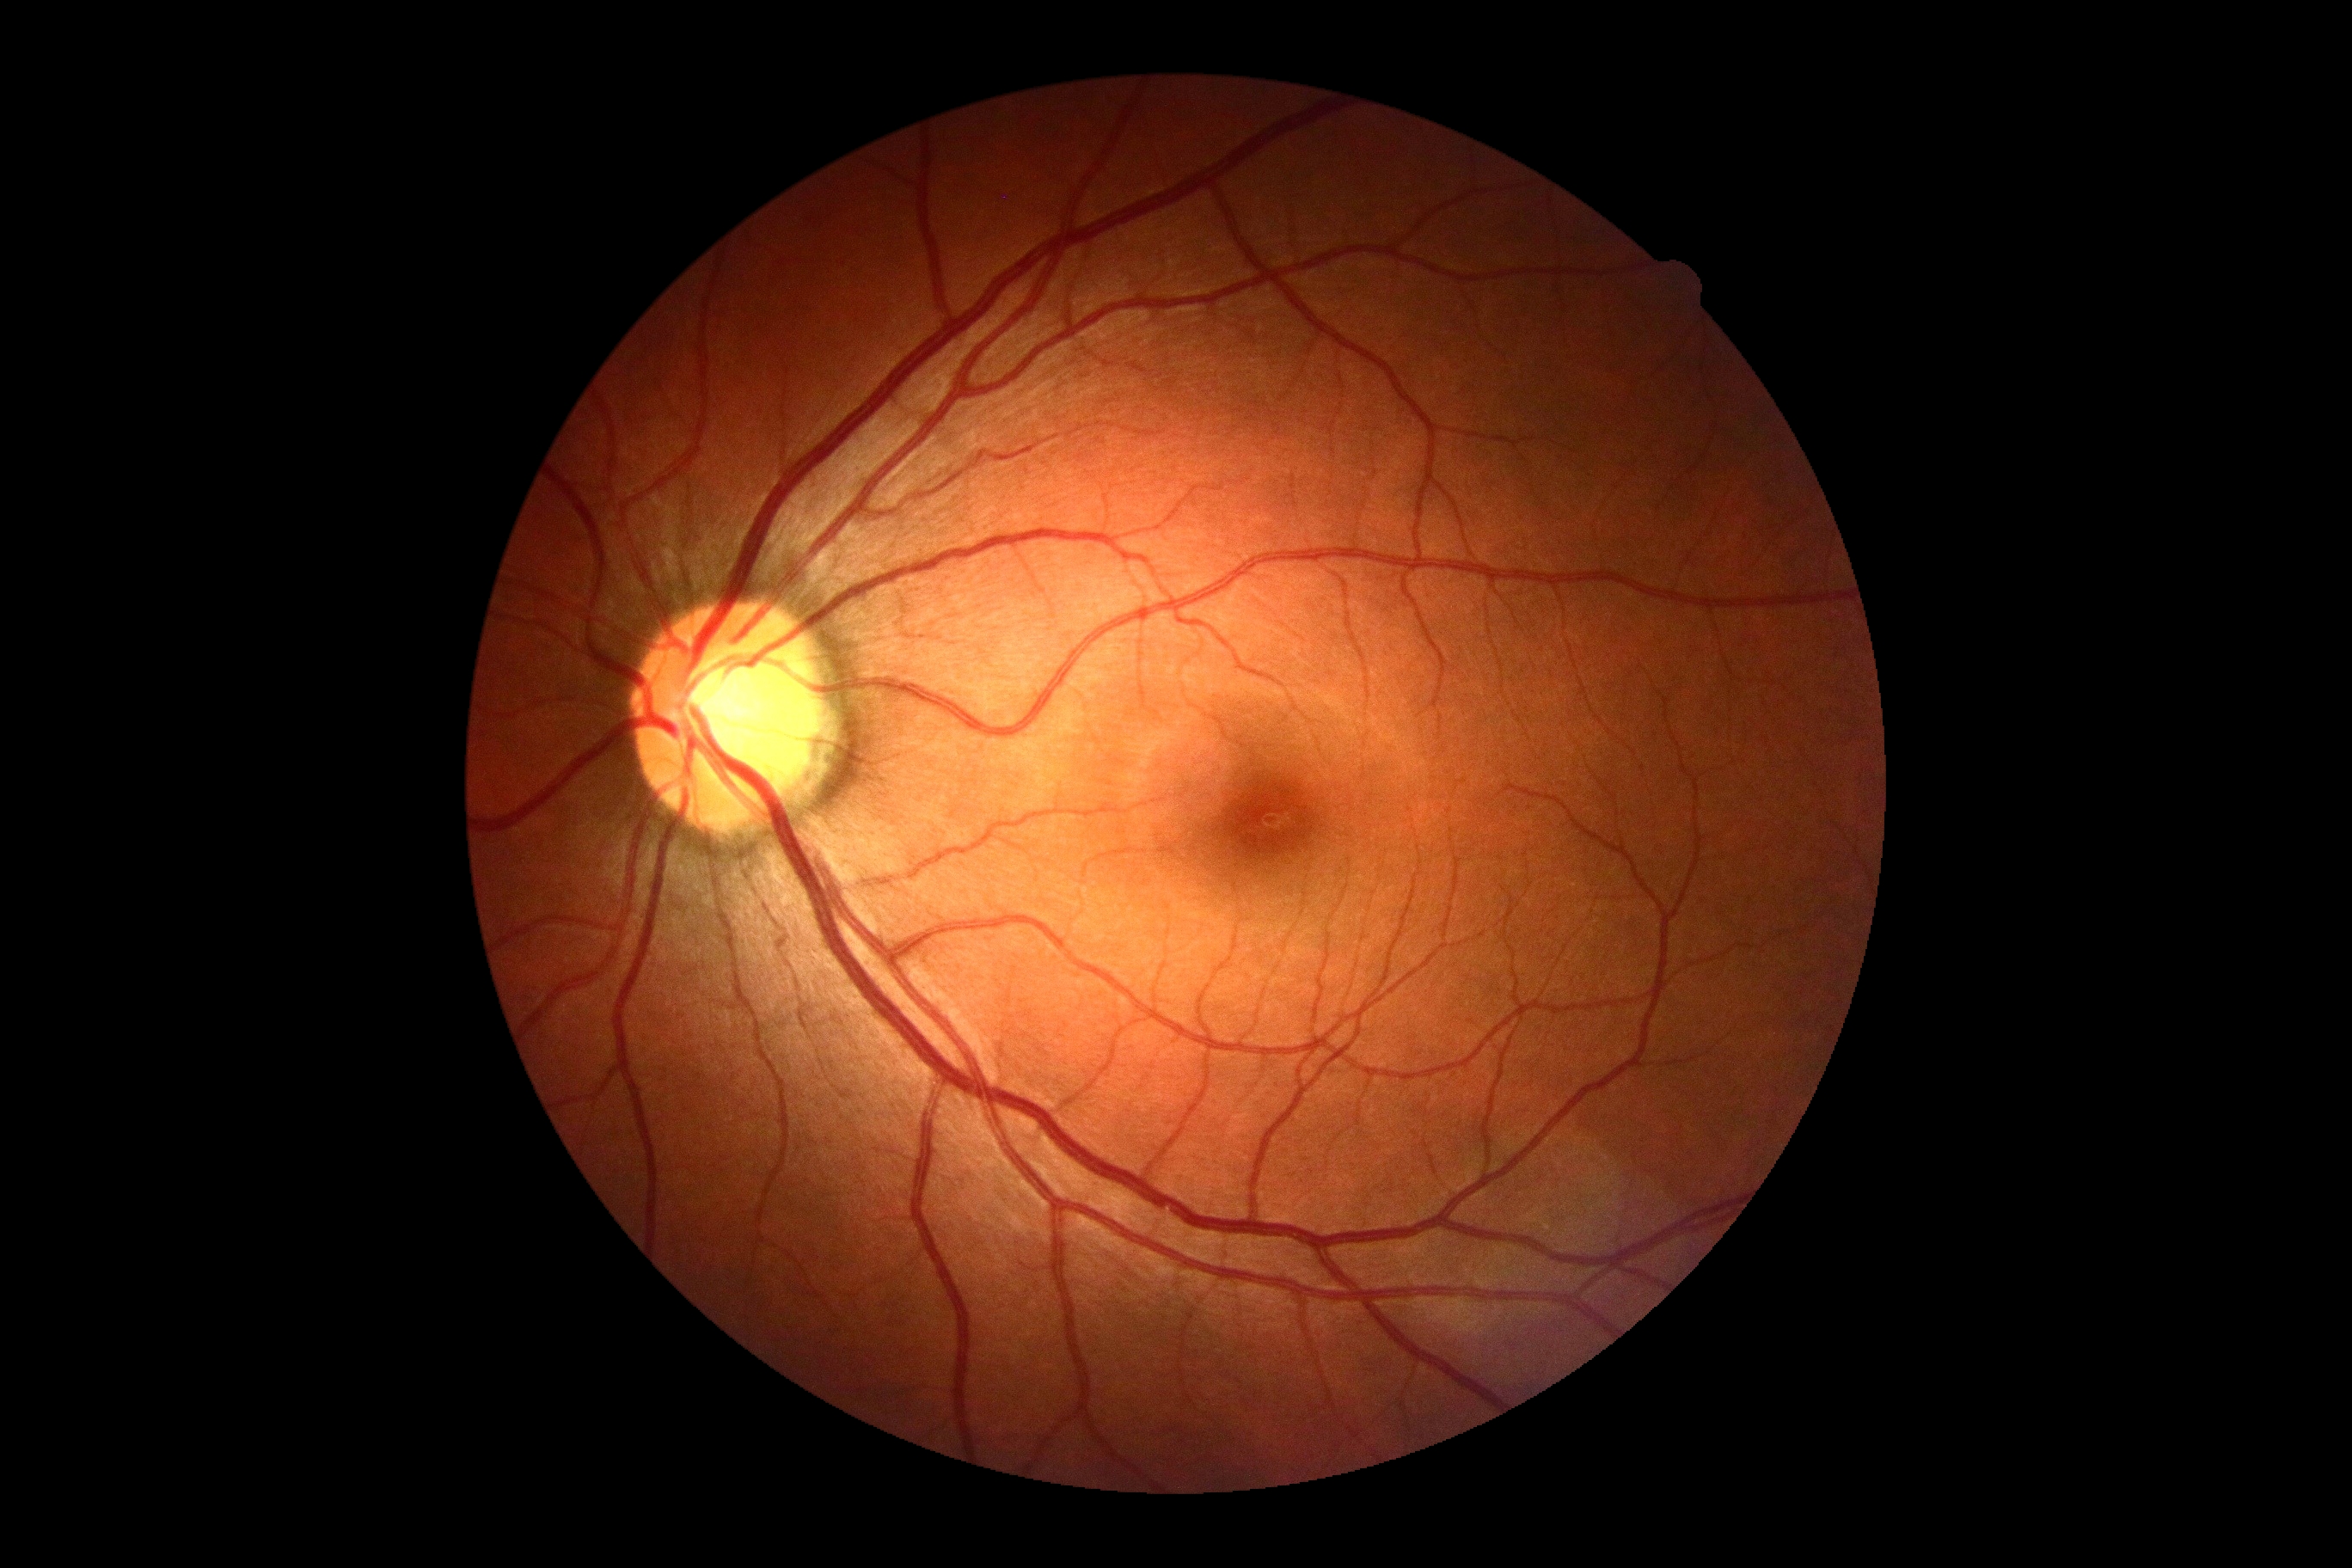

No diabetic retinal disease findings. DR severity is no apparent retinopathy (grade 0).